45° field of view: 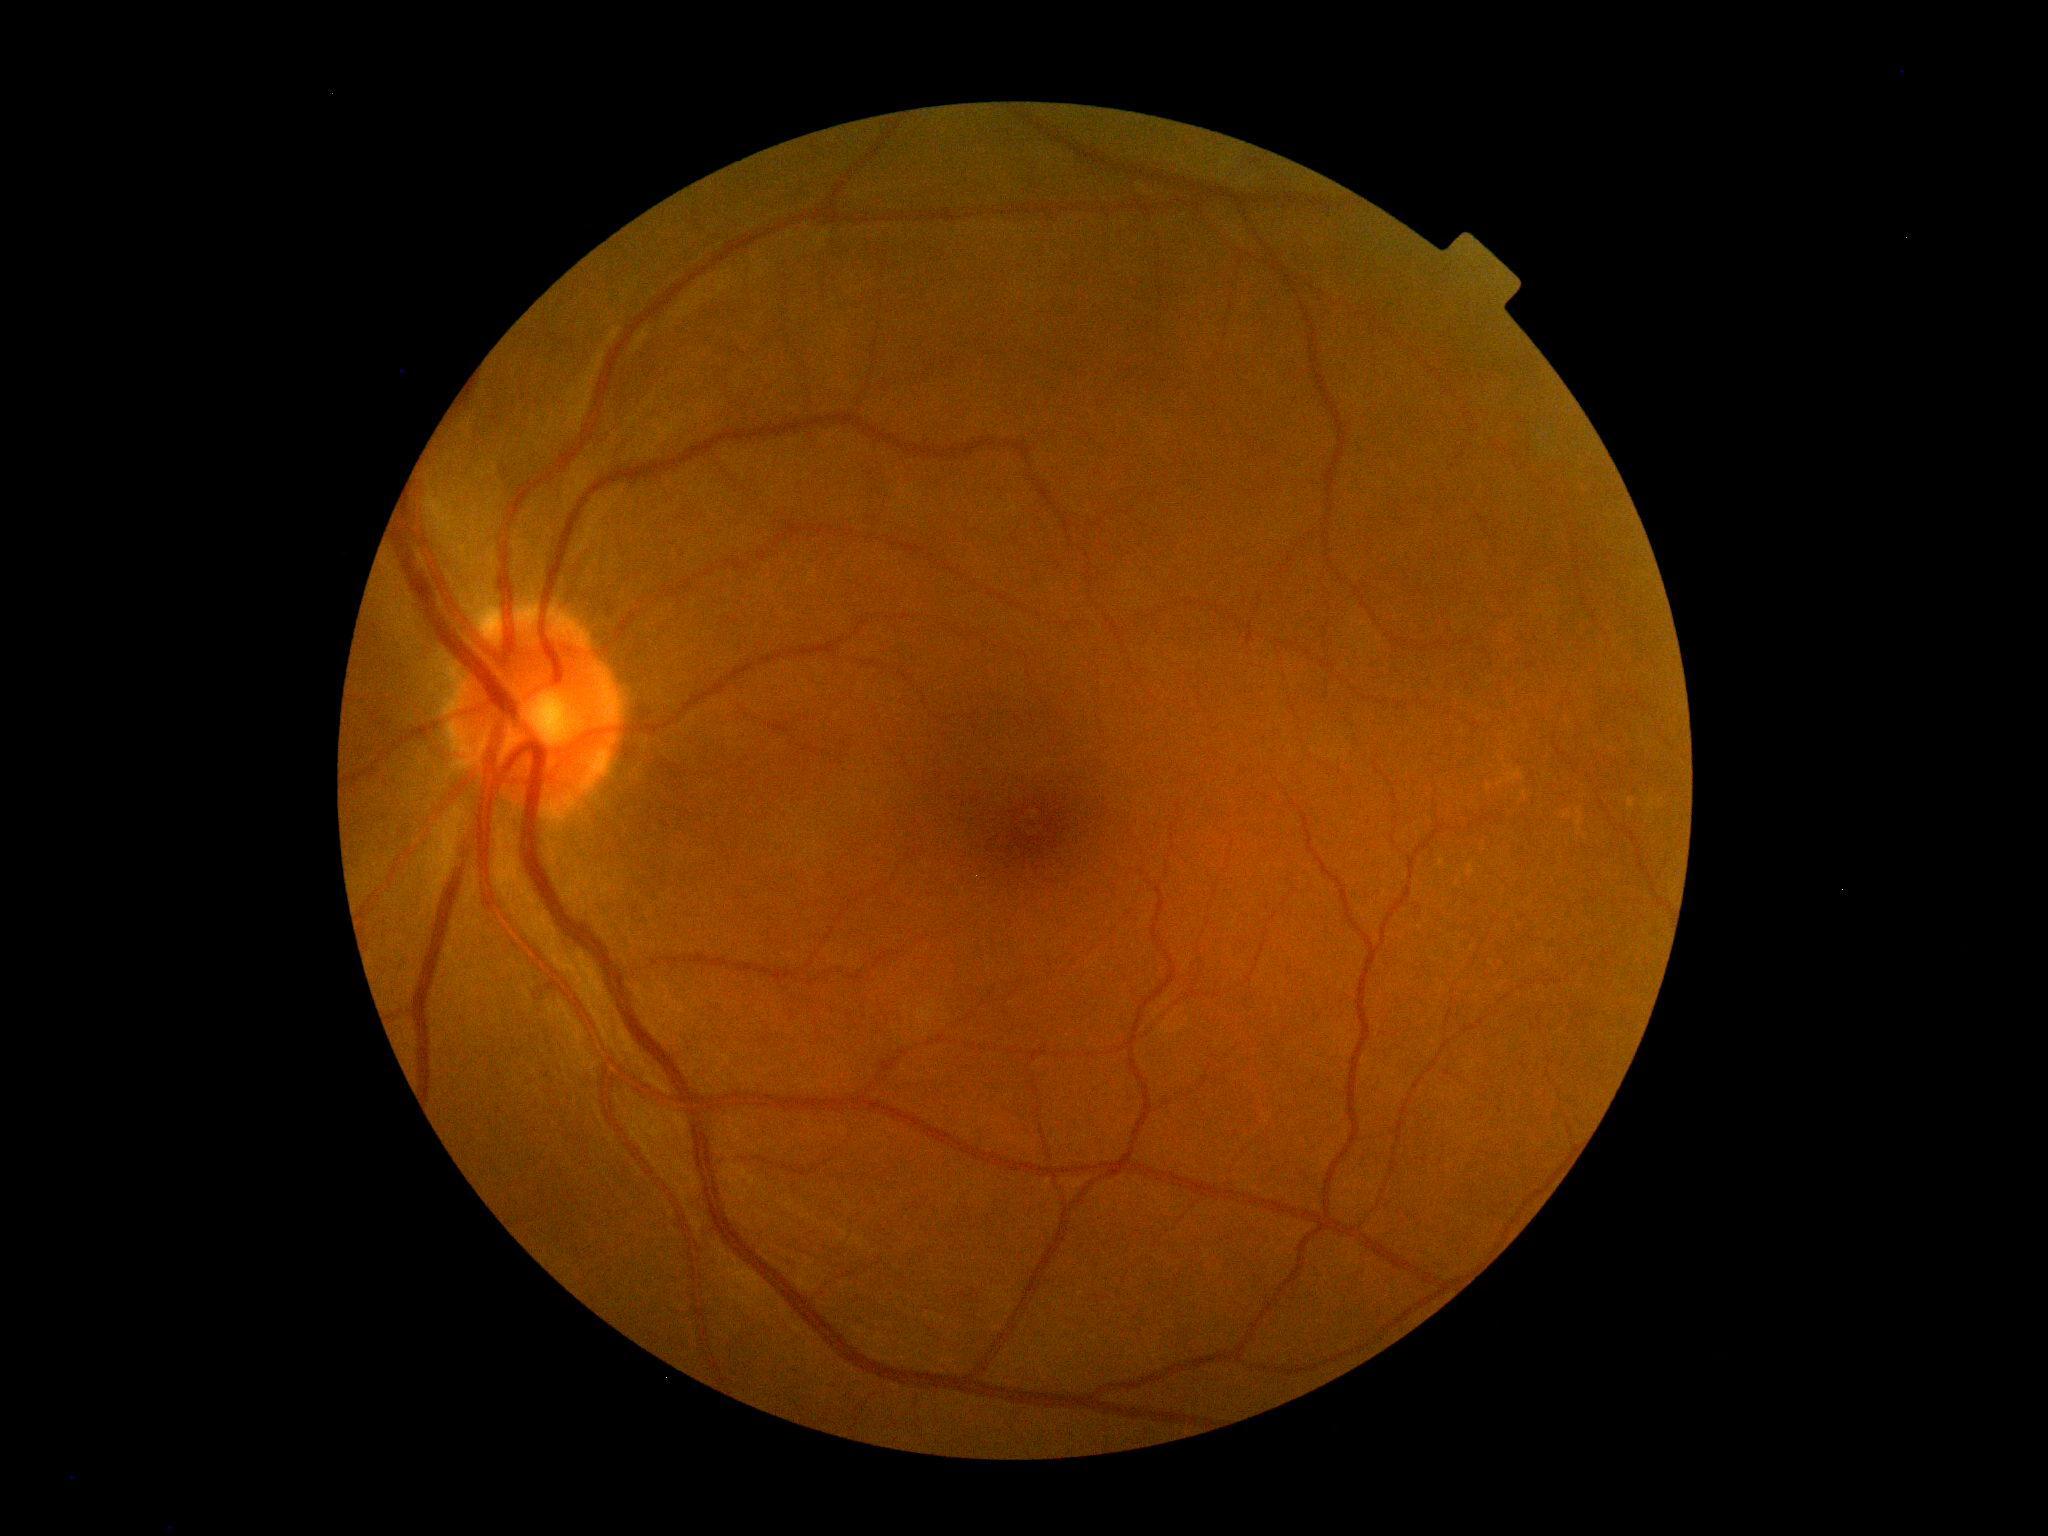
DR severity: grade 0 (no apparent retinopathy).